640x480; pediatric retinal photograph (wide-field); 130° field of view (Clarity RetCam 3) — 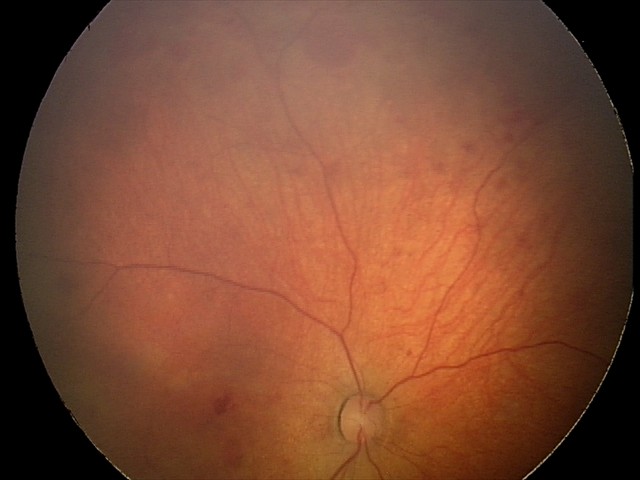

Screening series with retinal hemorrhages.